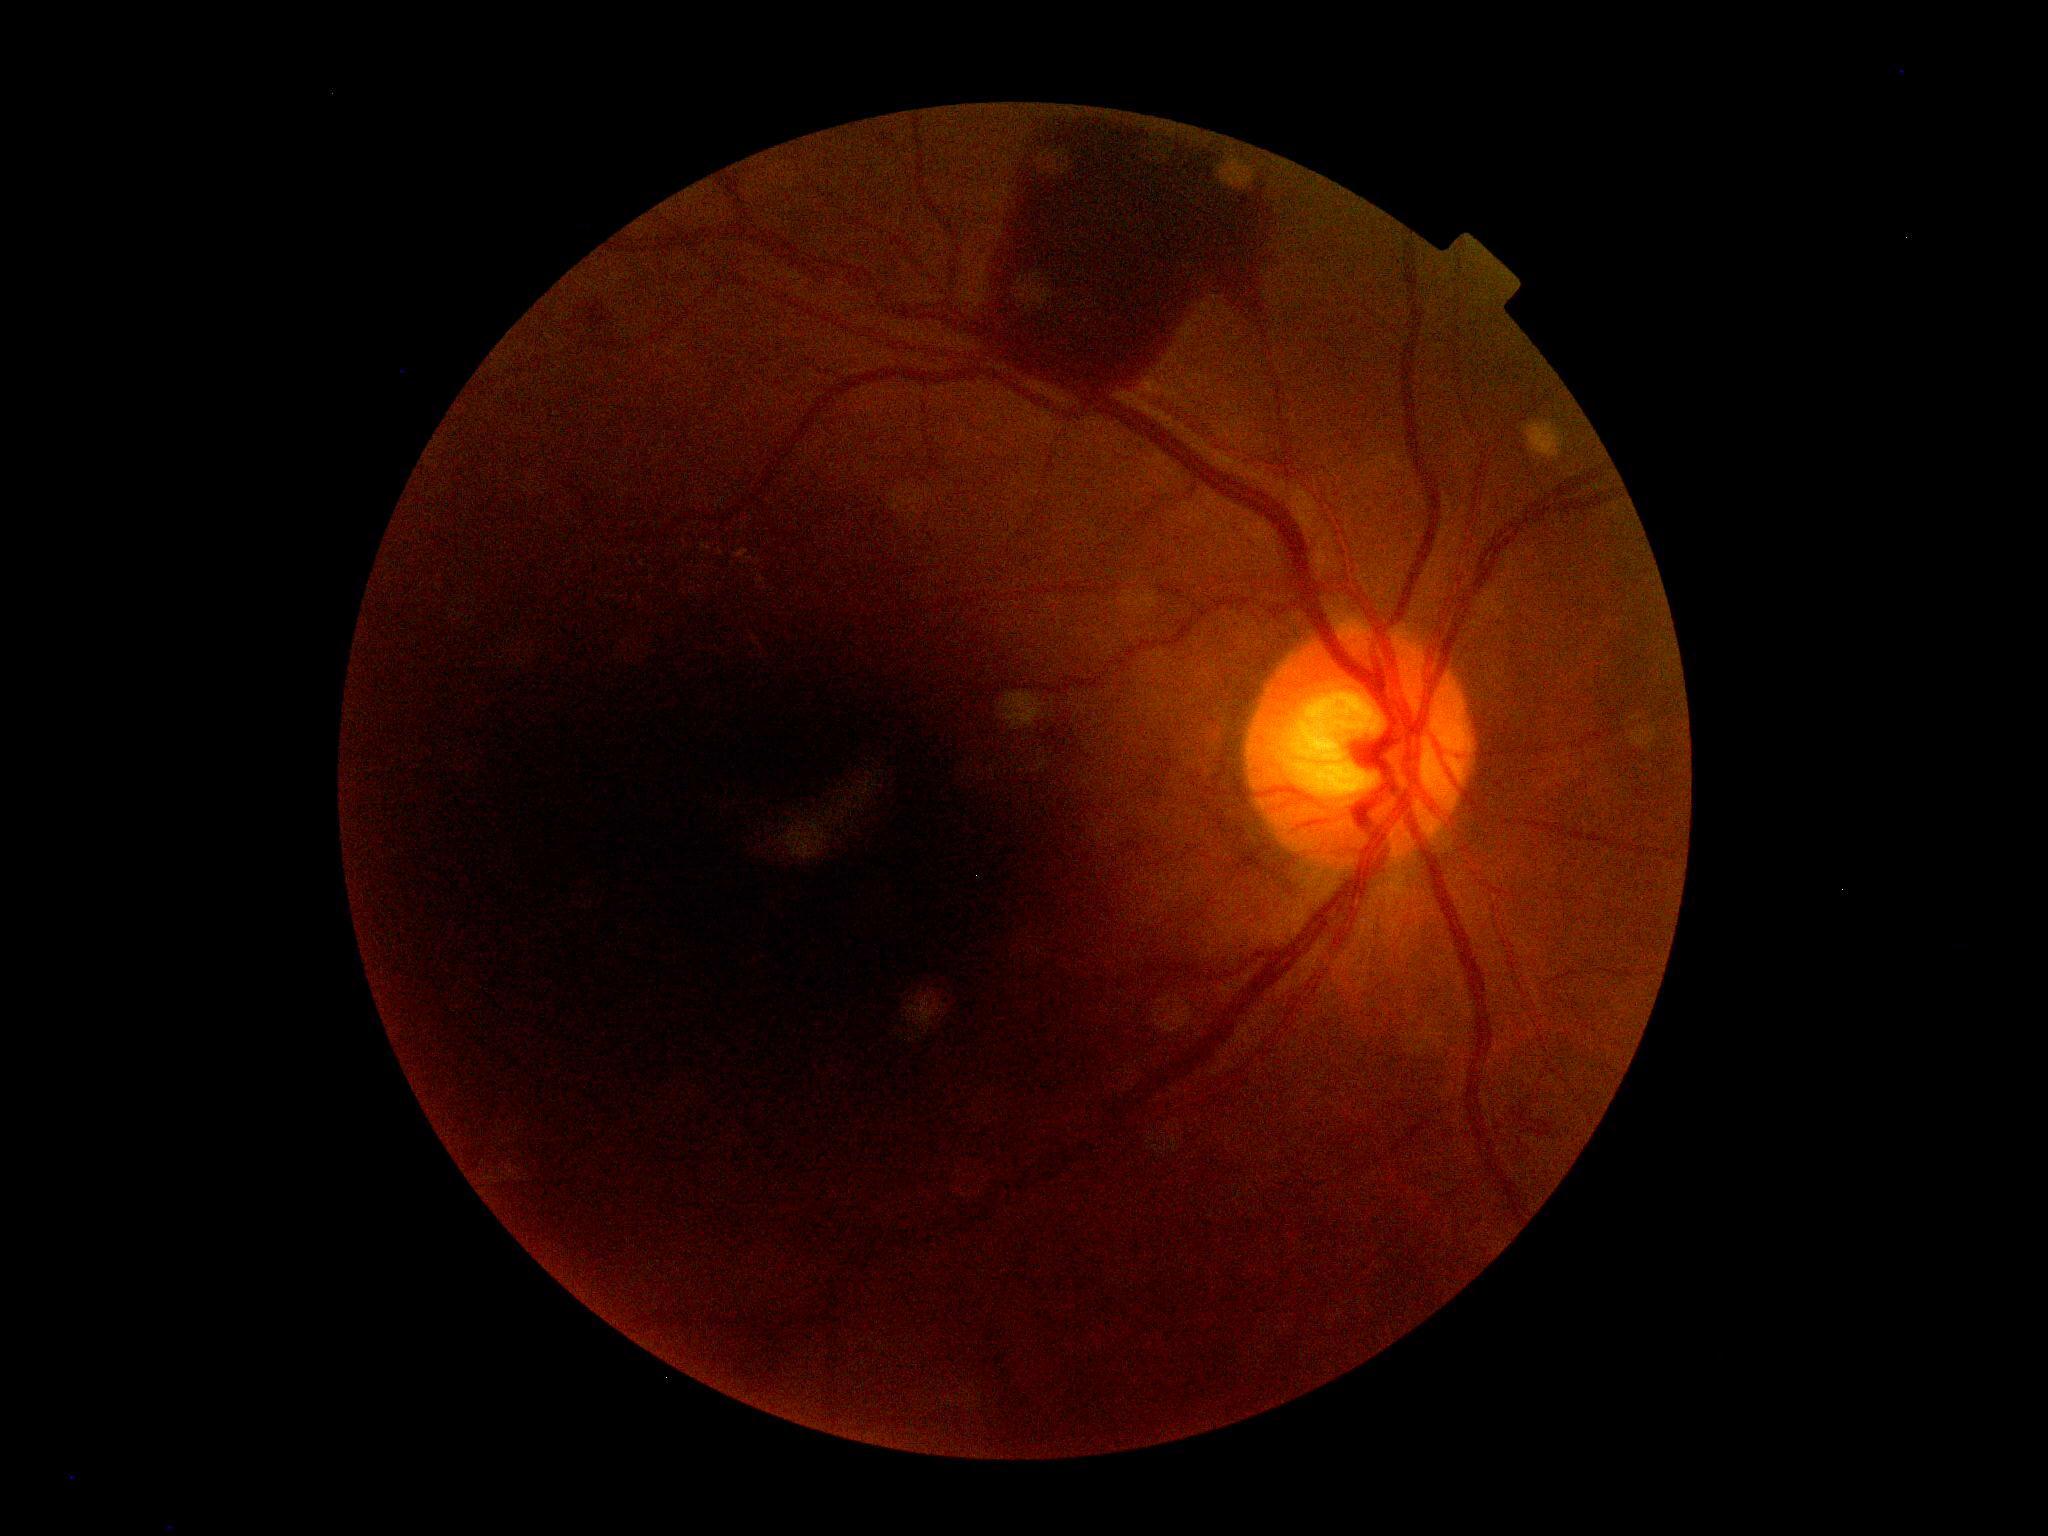
diabetic retinopathy=4.